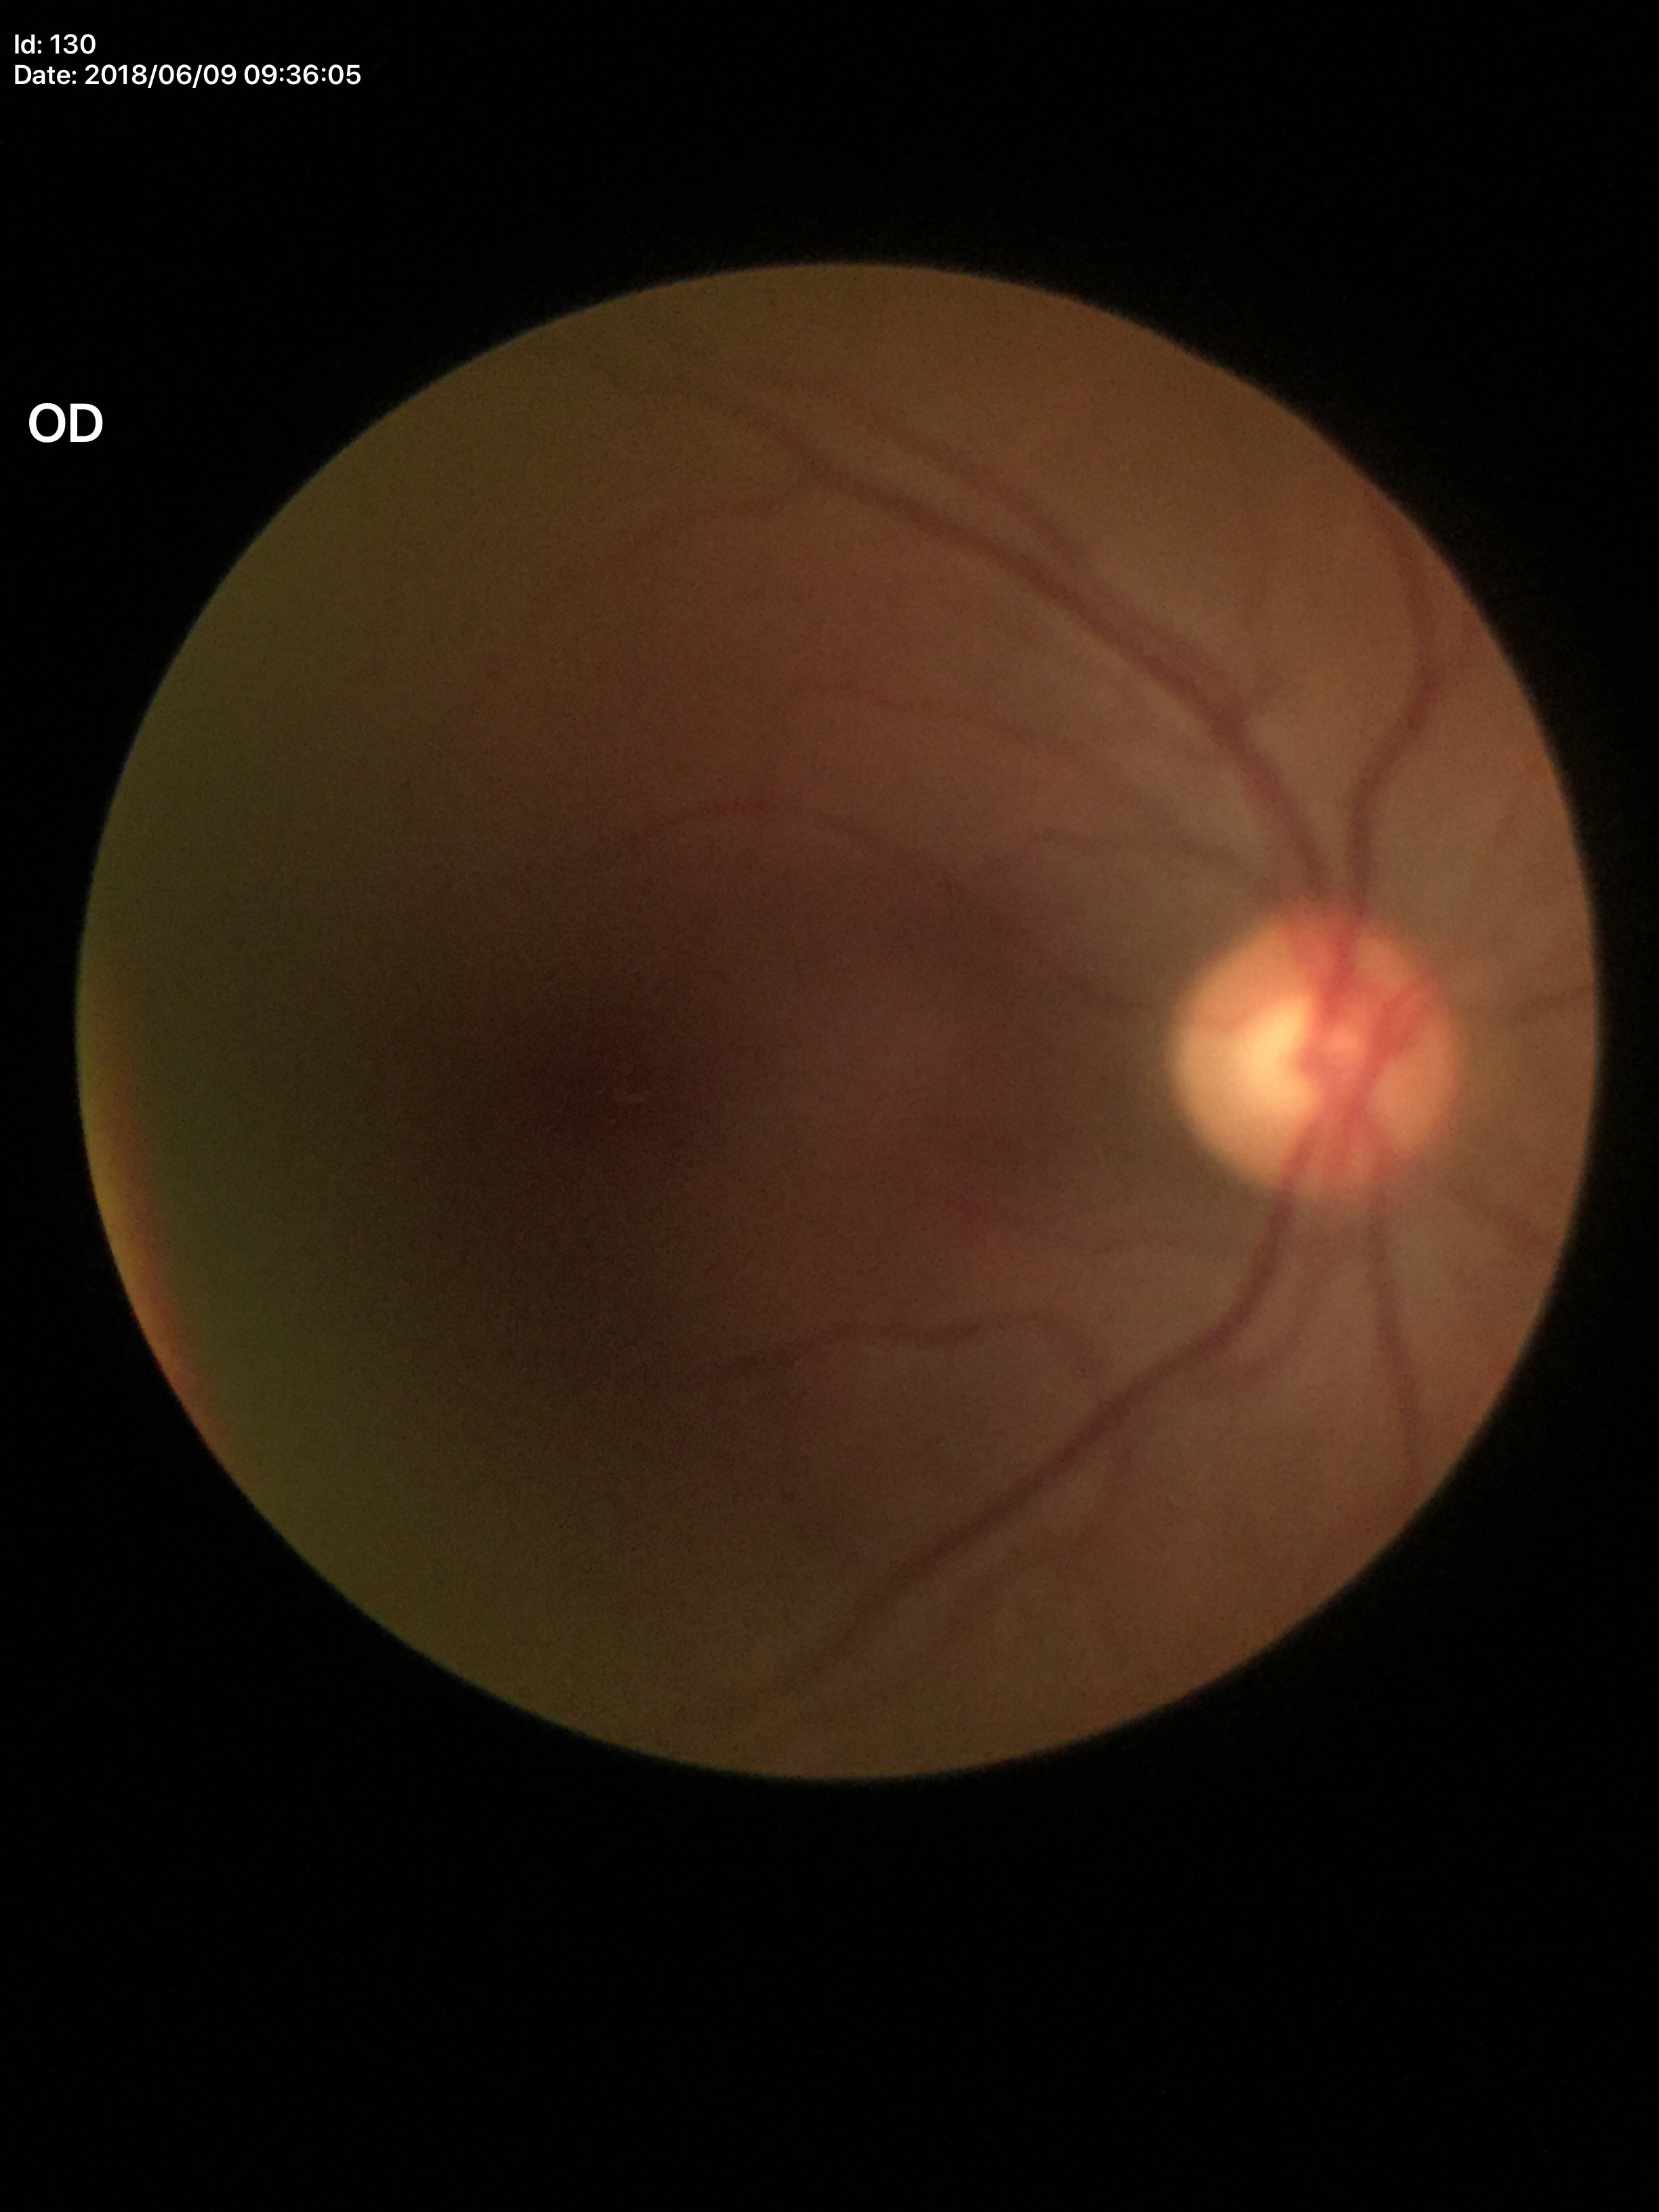 • Glaucoma screening · negative
• horizontal C/D ratio (HCDR) · 0.52
• vertical C/D ratio (VCDR) · 0.51